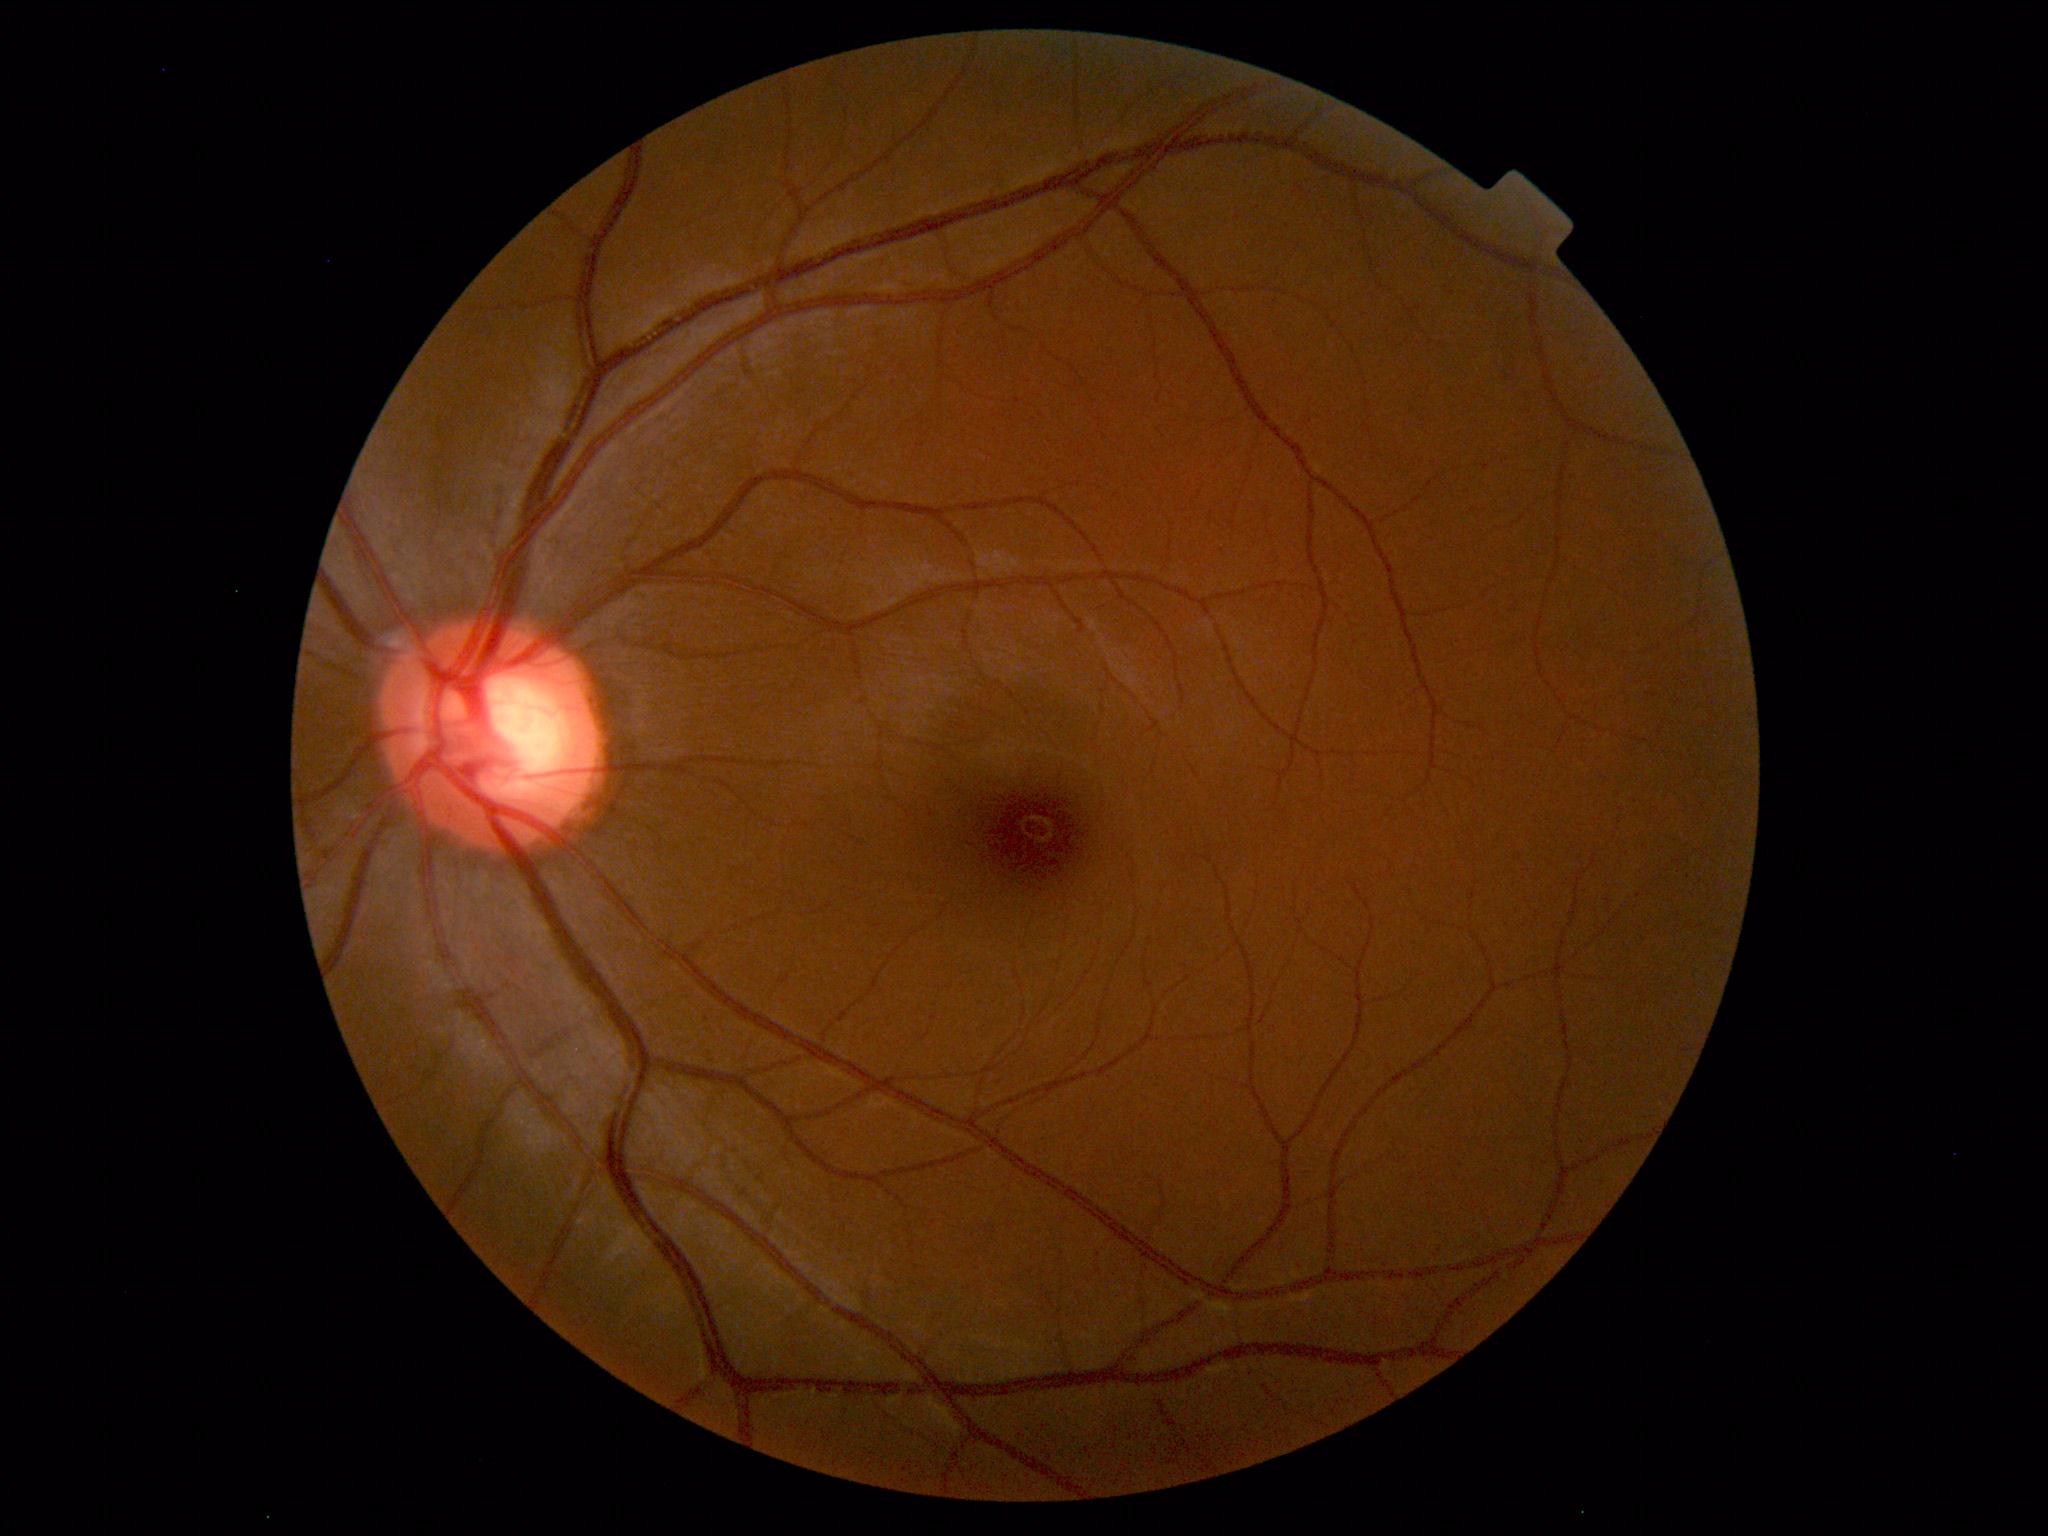

Impression: normal fundus.